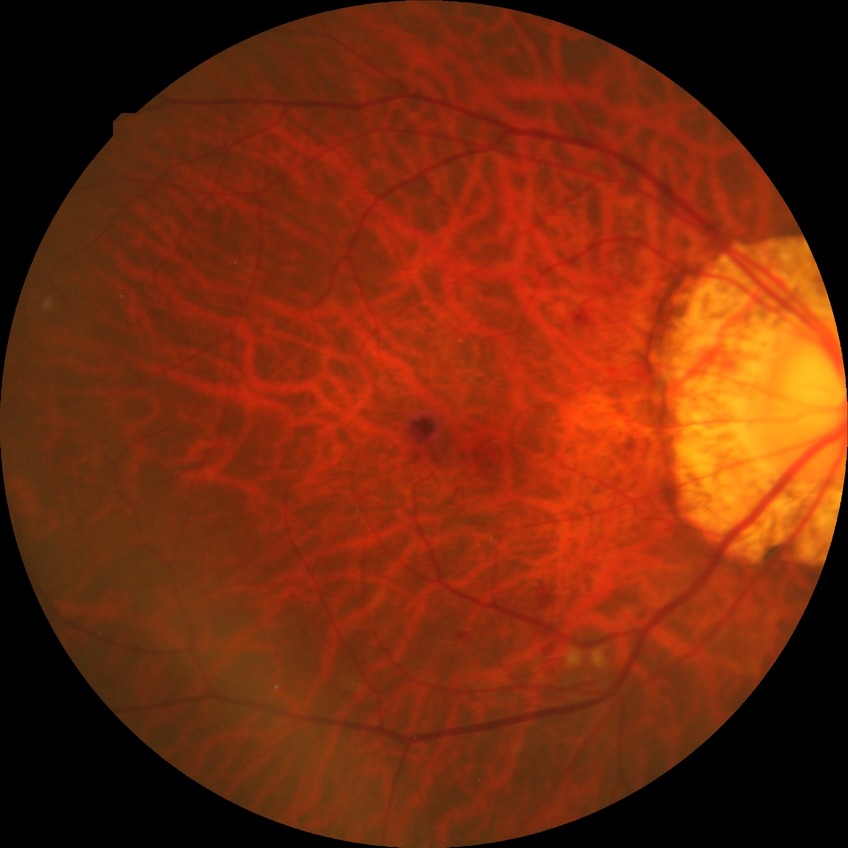
DR severity: PPDR.